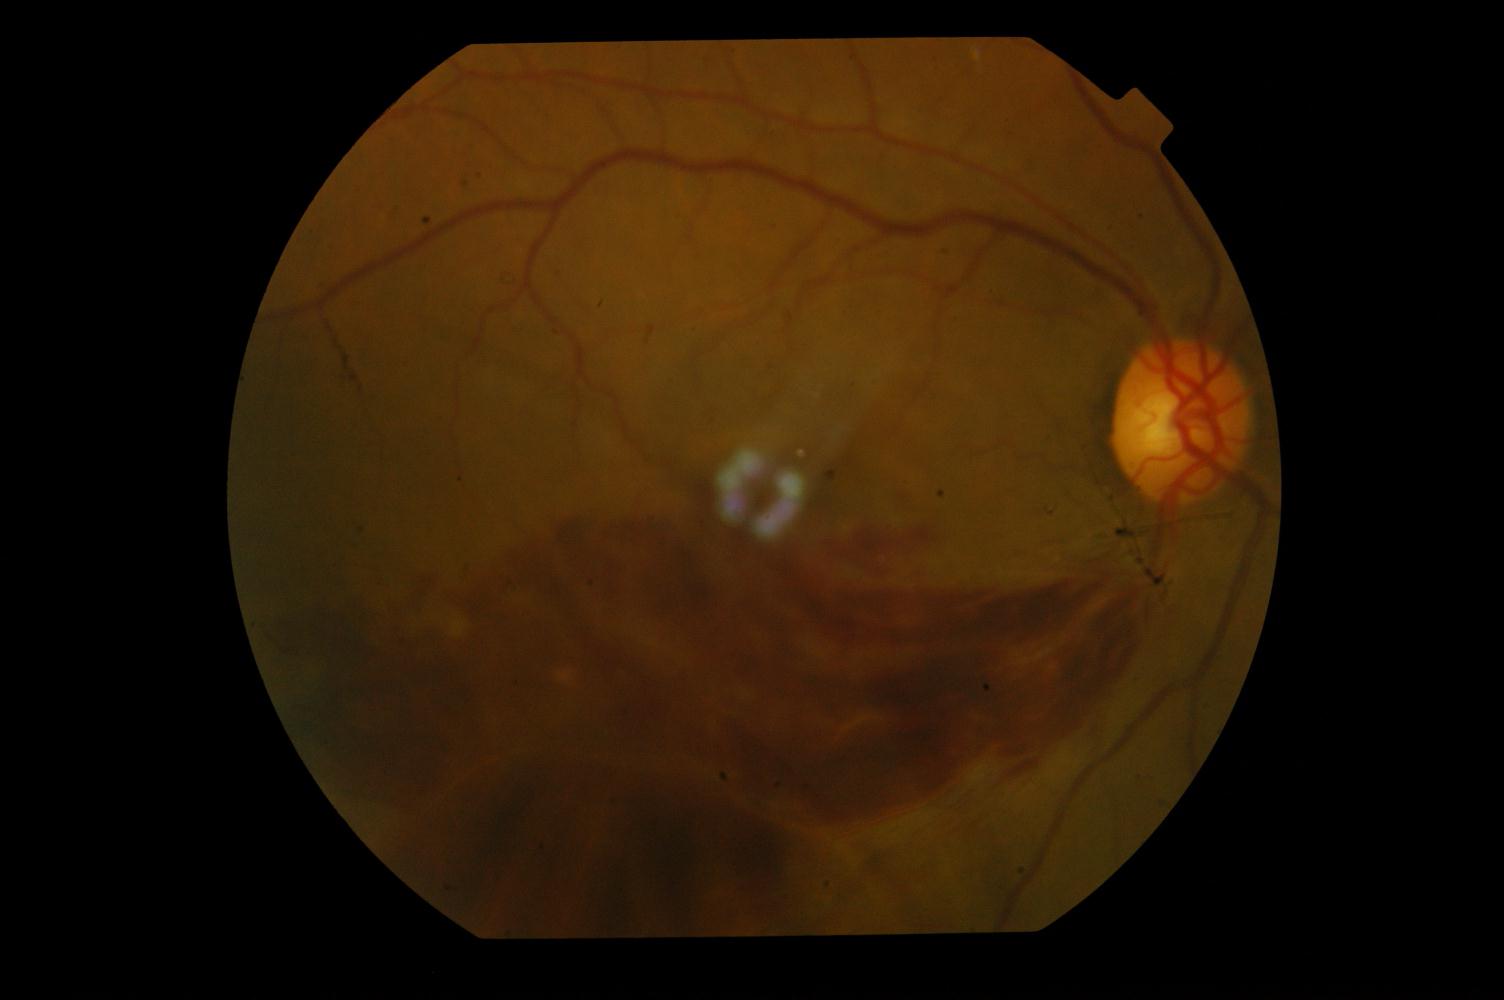

The image shows branch retinal vein occlusion.